DR severity per modified Davis staging
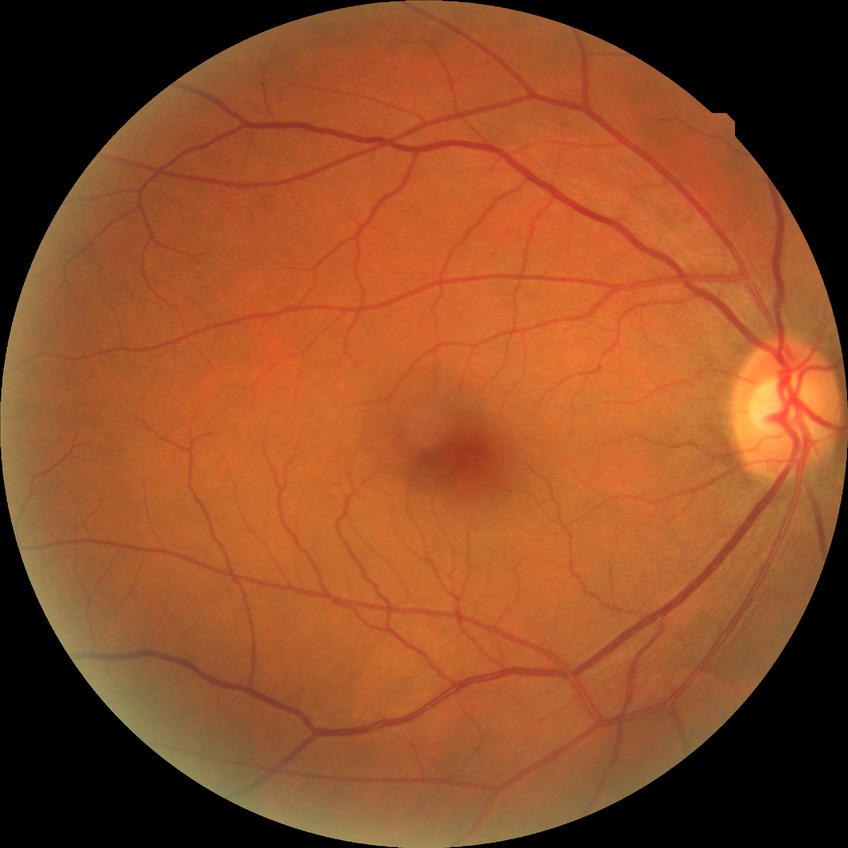 Assessment:
– diabetic retinopathy (DR): no diabetic retinopathy (NDR)